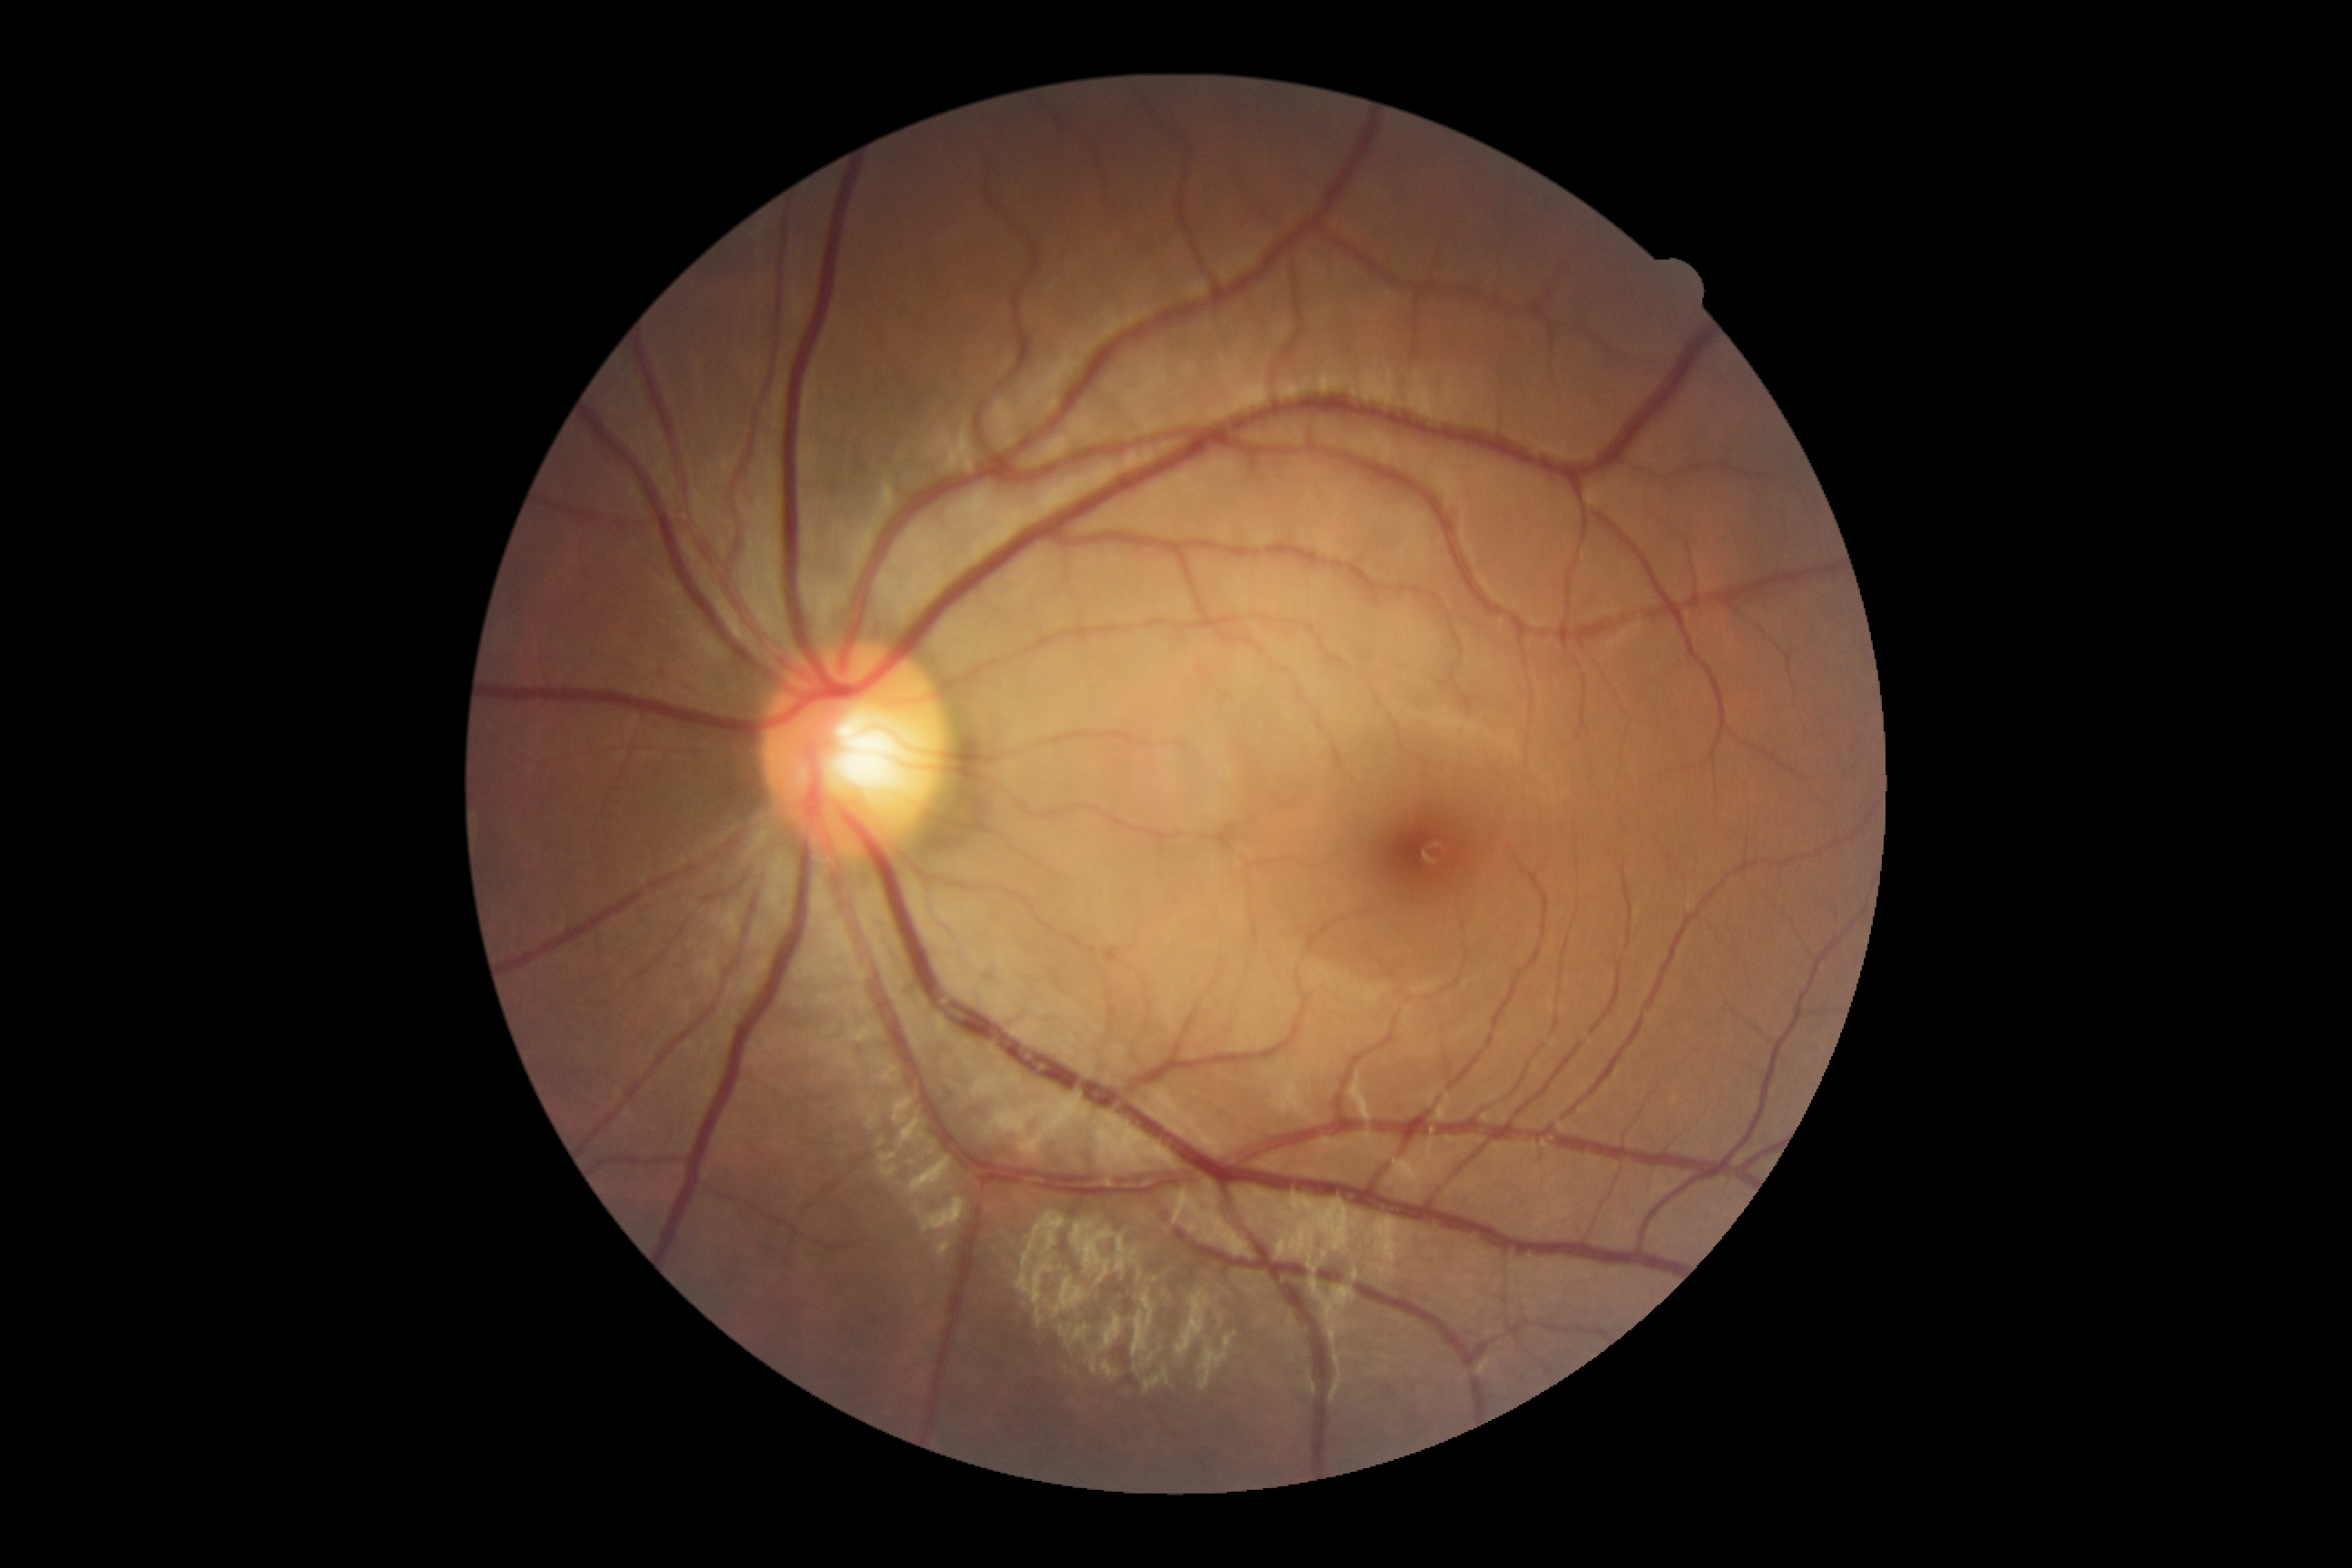
DR grade is 0 (no apparent retinopathy).